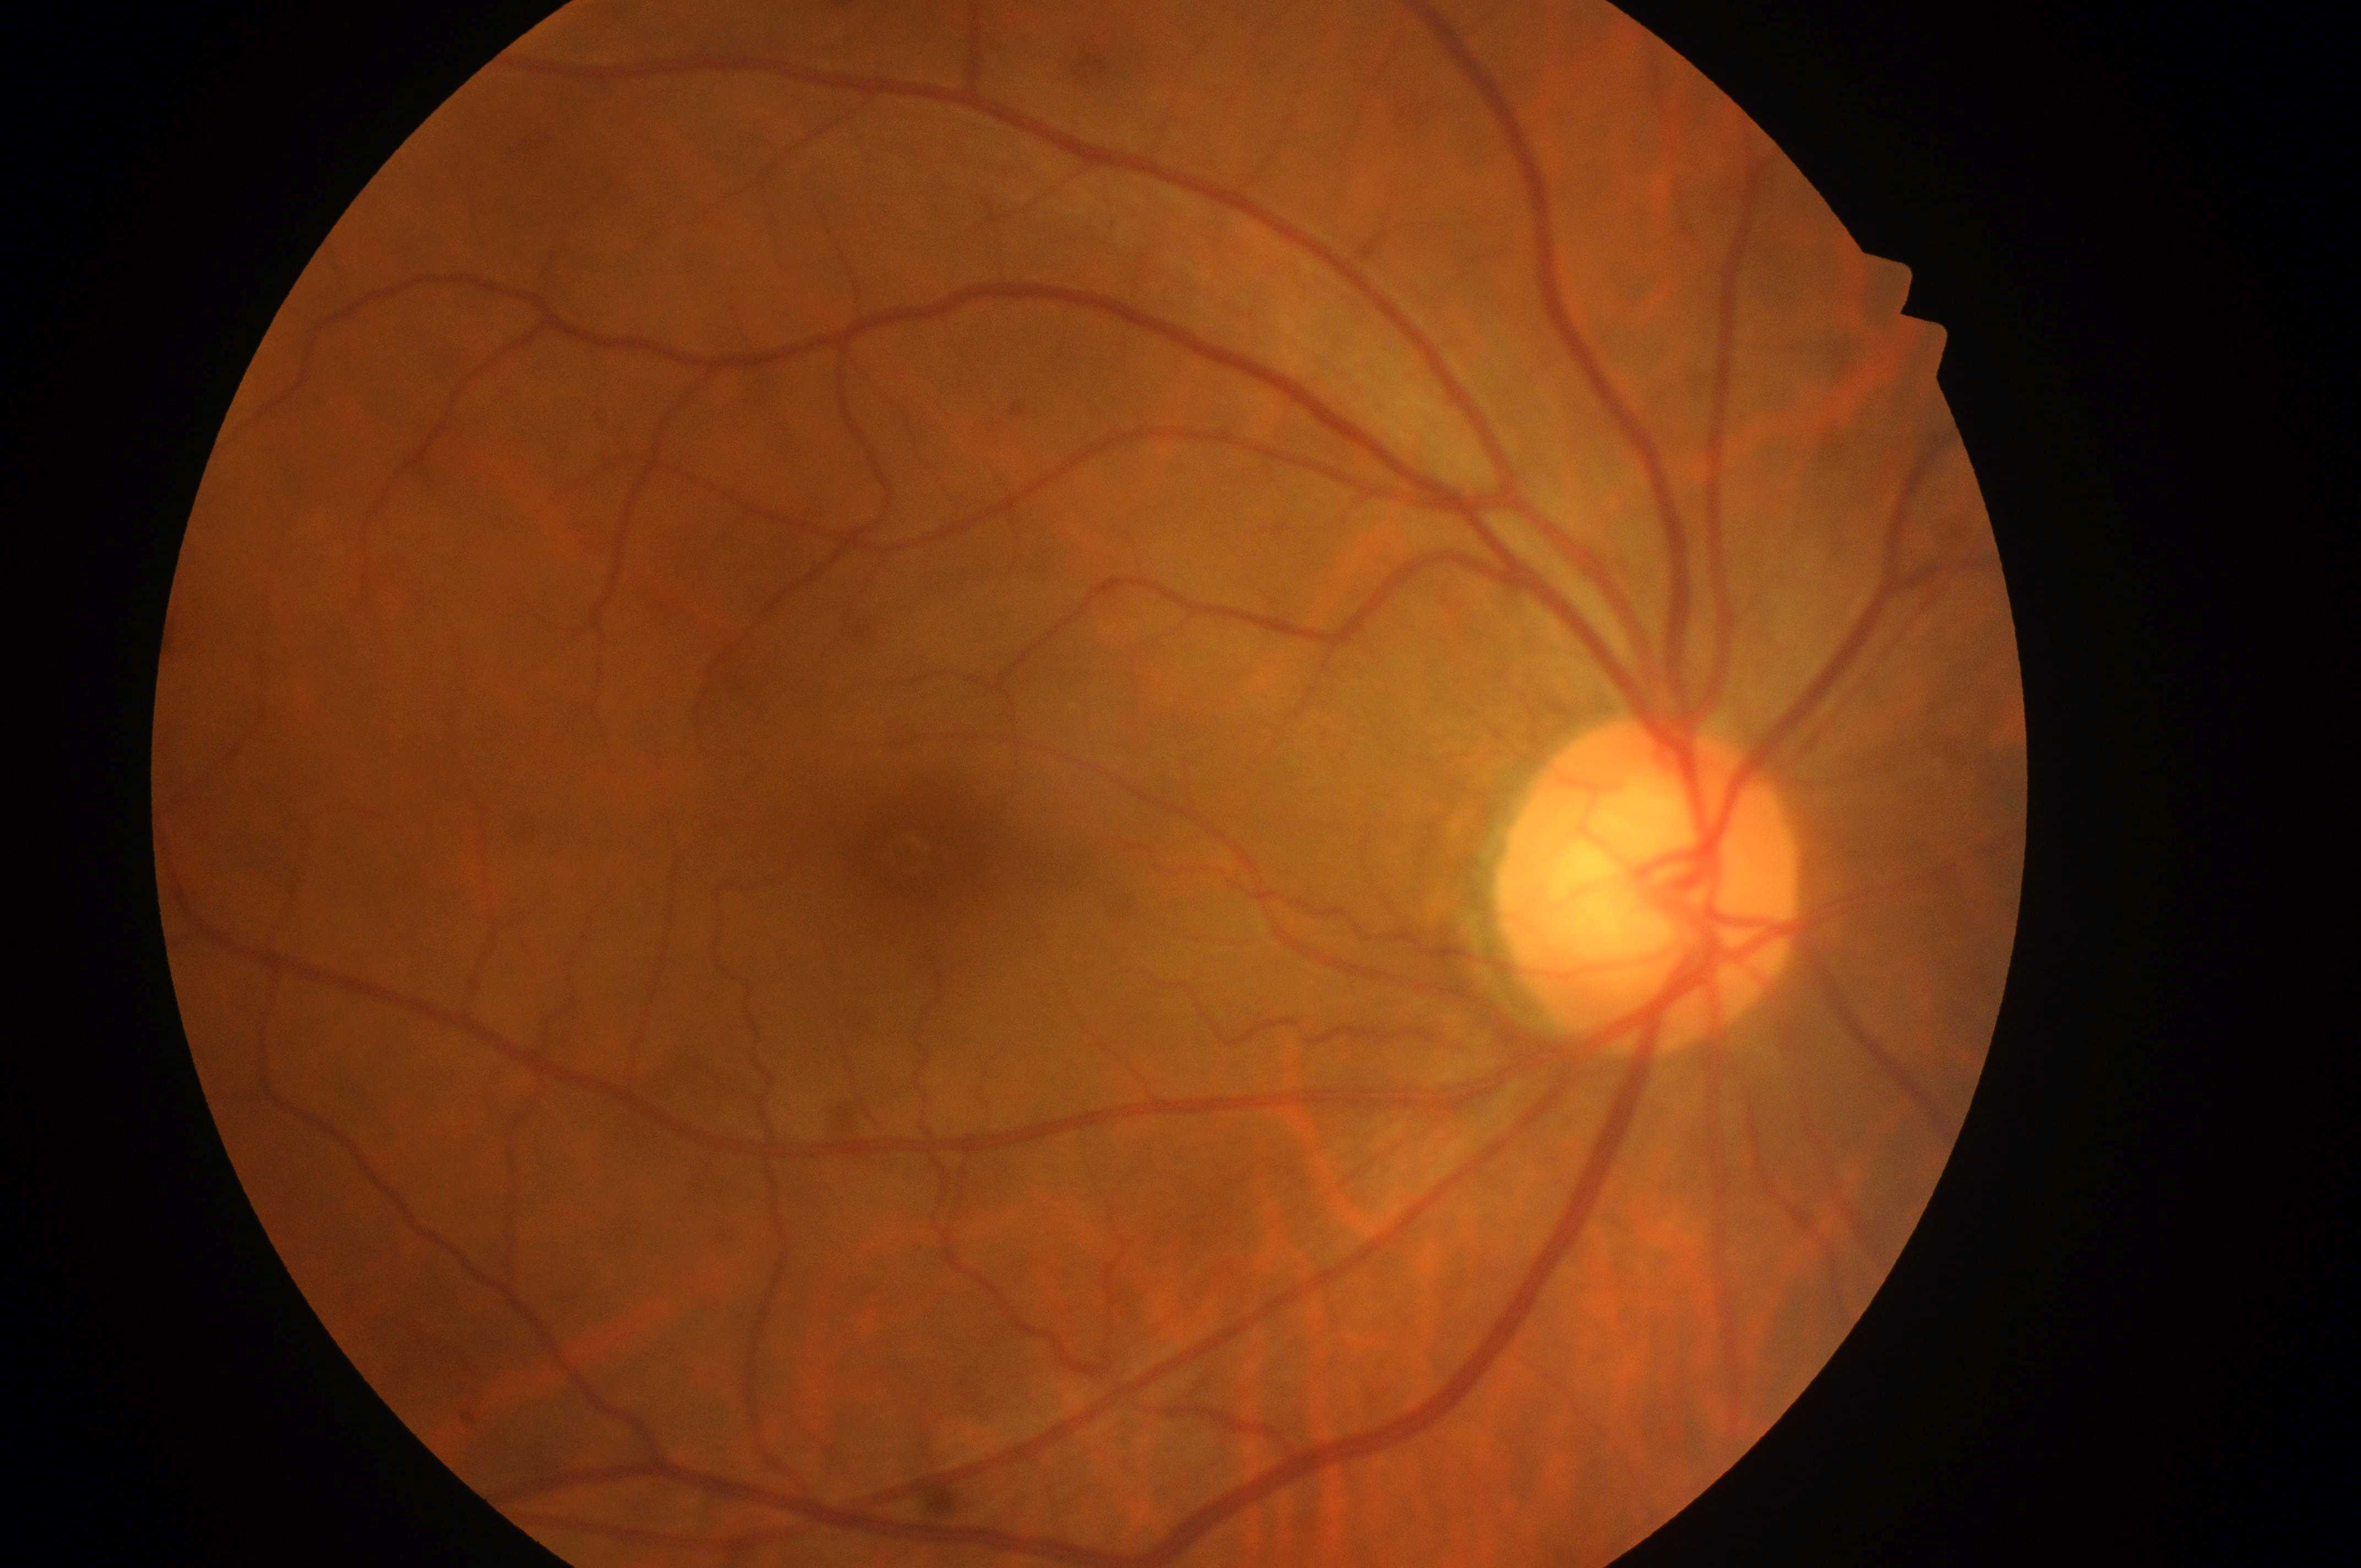 Optic disc: x=1644, y=905.
Fovea centralis: x=938, y=853.
No signs of diabetic retinopathy or diabetic macular edema.
DME grade is no risk (0).
The image shows the oculus dexter.
DR stage is no apparent diabetic retinopathy (grade 0).